Color fundus image:
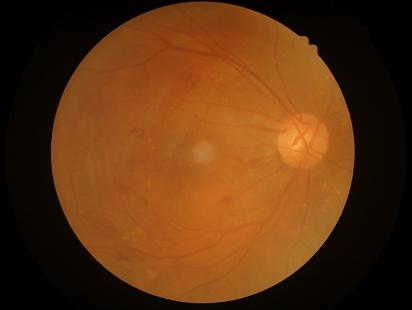
Contrast: adequate; Overall quality: poor; Clarity: poor.